Retinal fundus photograph, 1932 by 1932 pixels
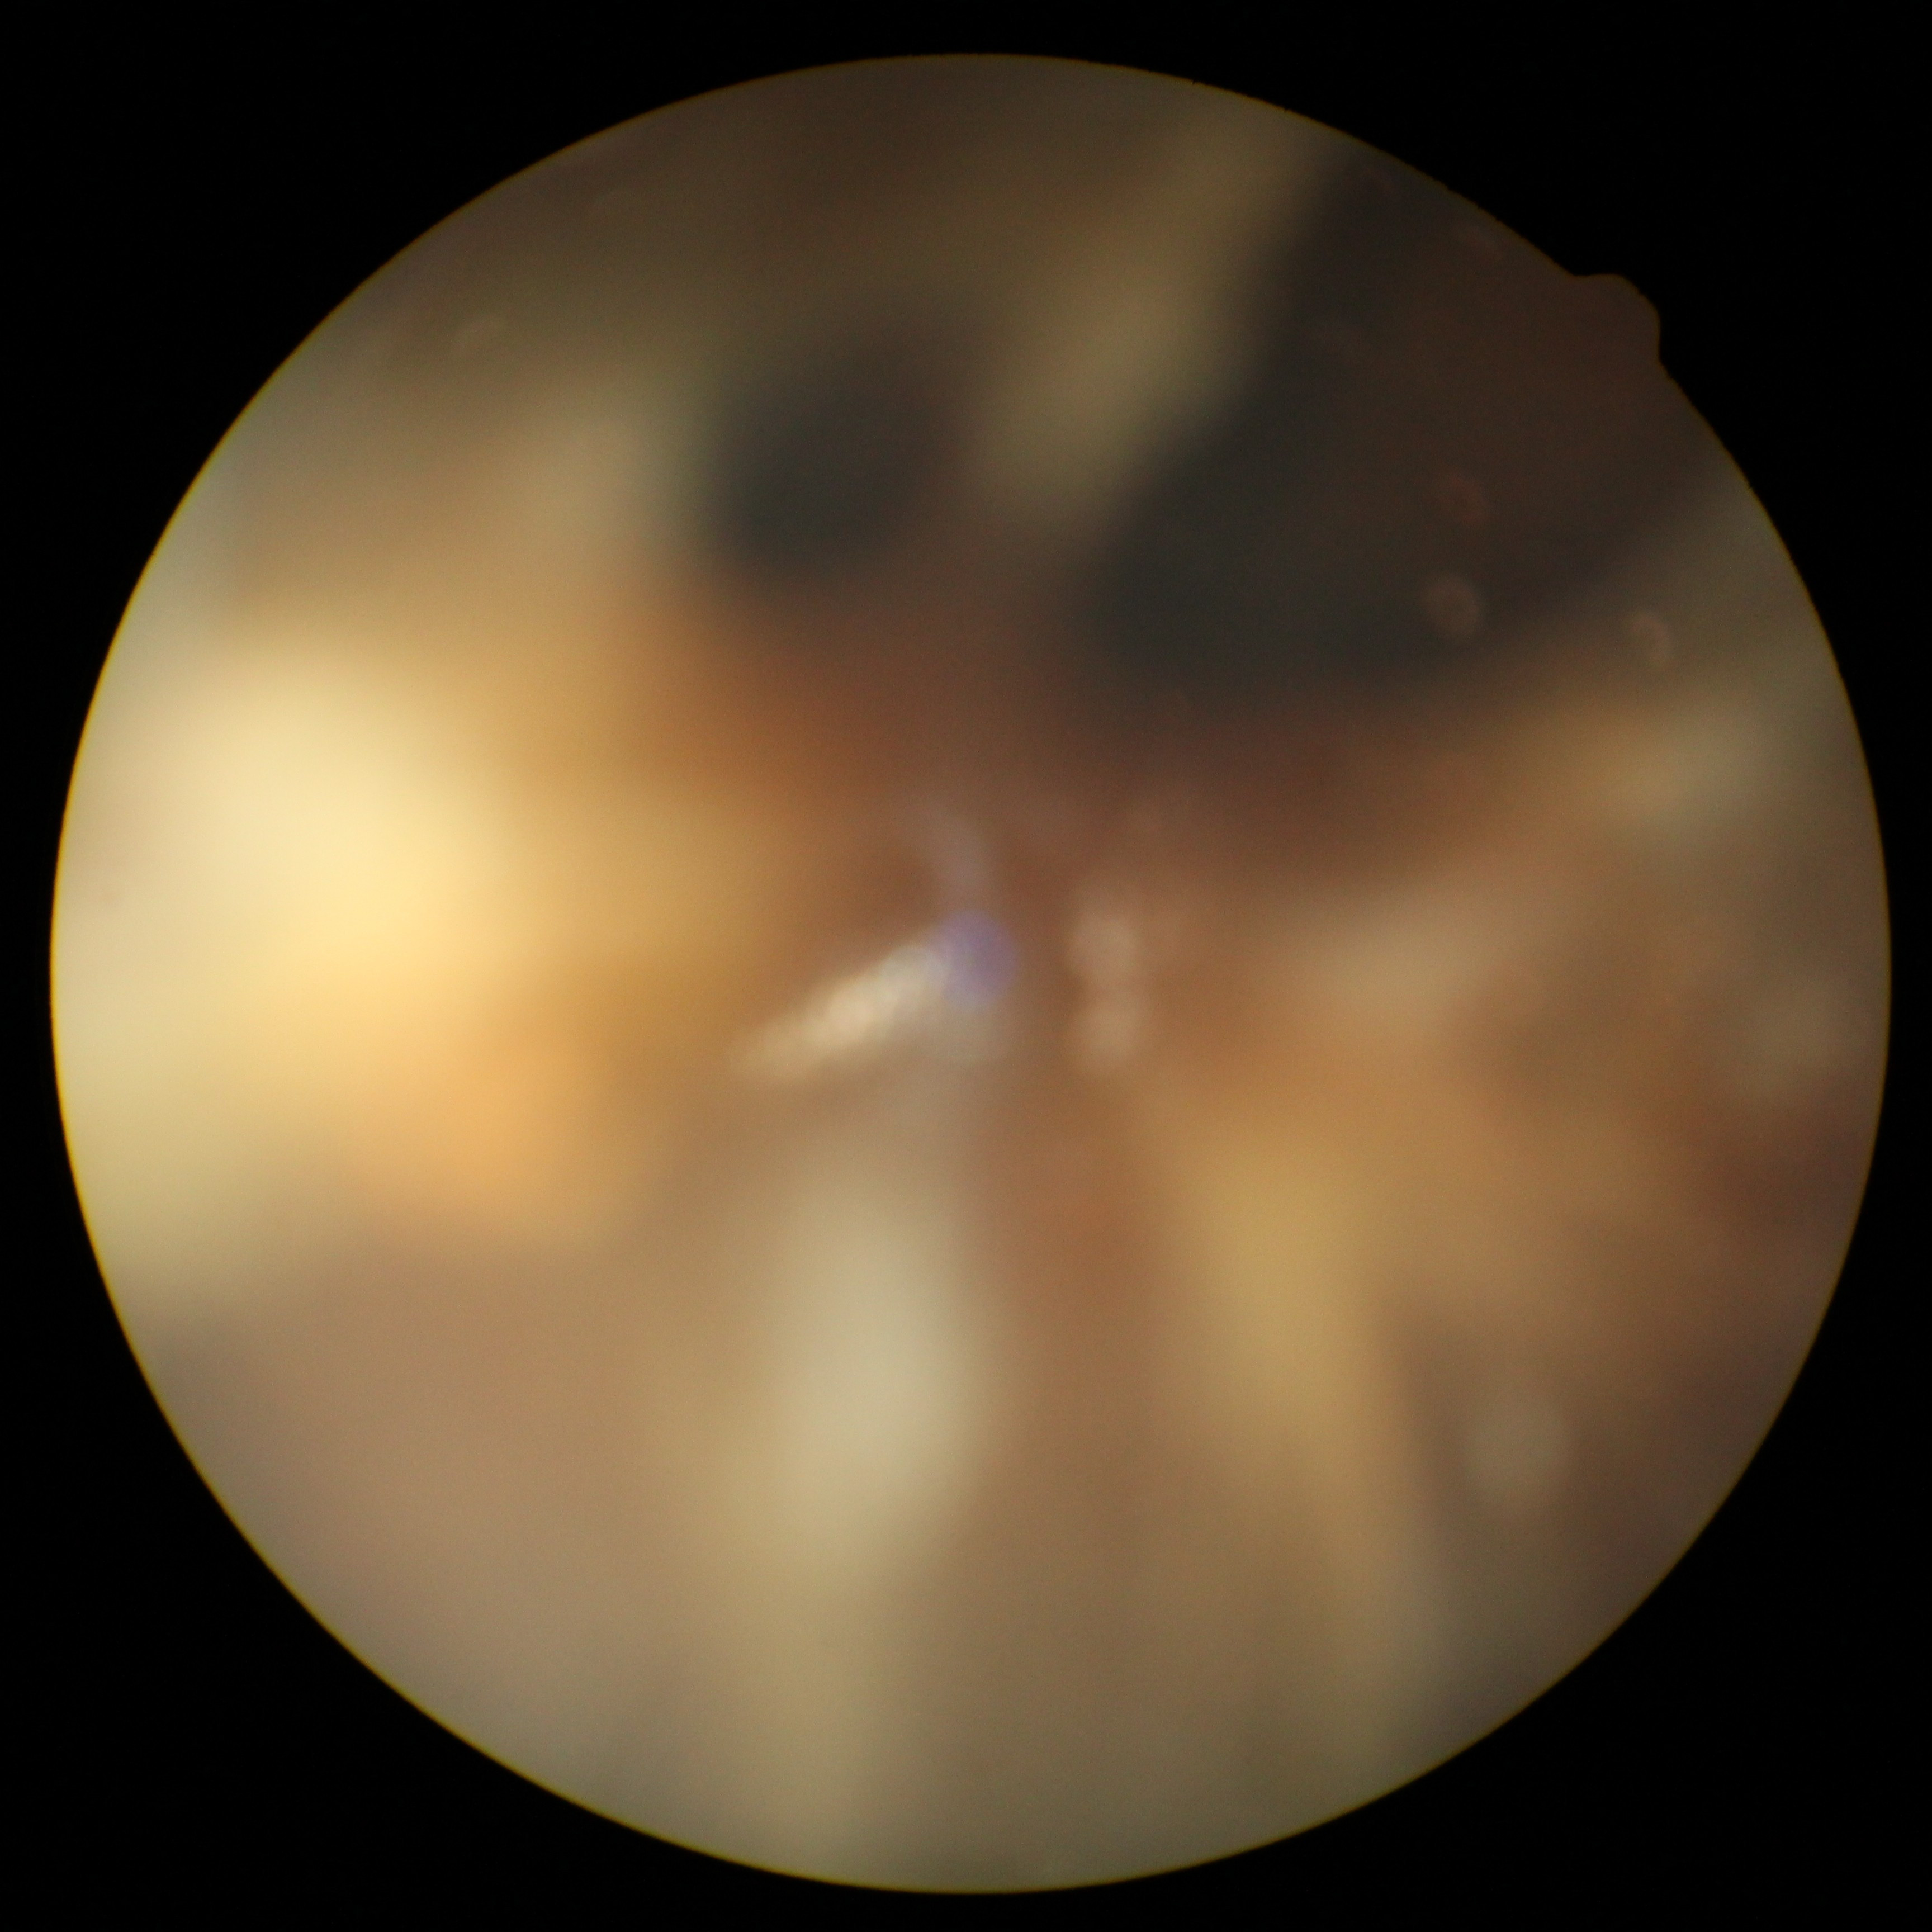
diabetic retinopathy grade: ungradable due to poor image quality | image quality: too poor for DR grading.